1240x1240. Wide-field fundus photograph of an infant. Camera: Phoenix ICON (100° FOV)
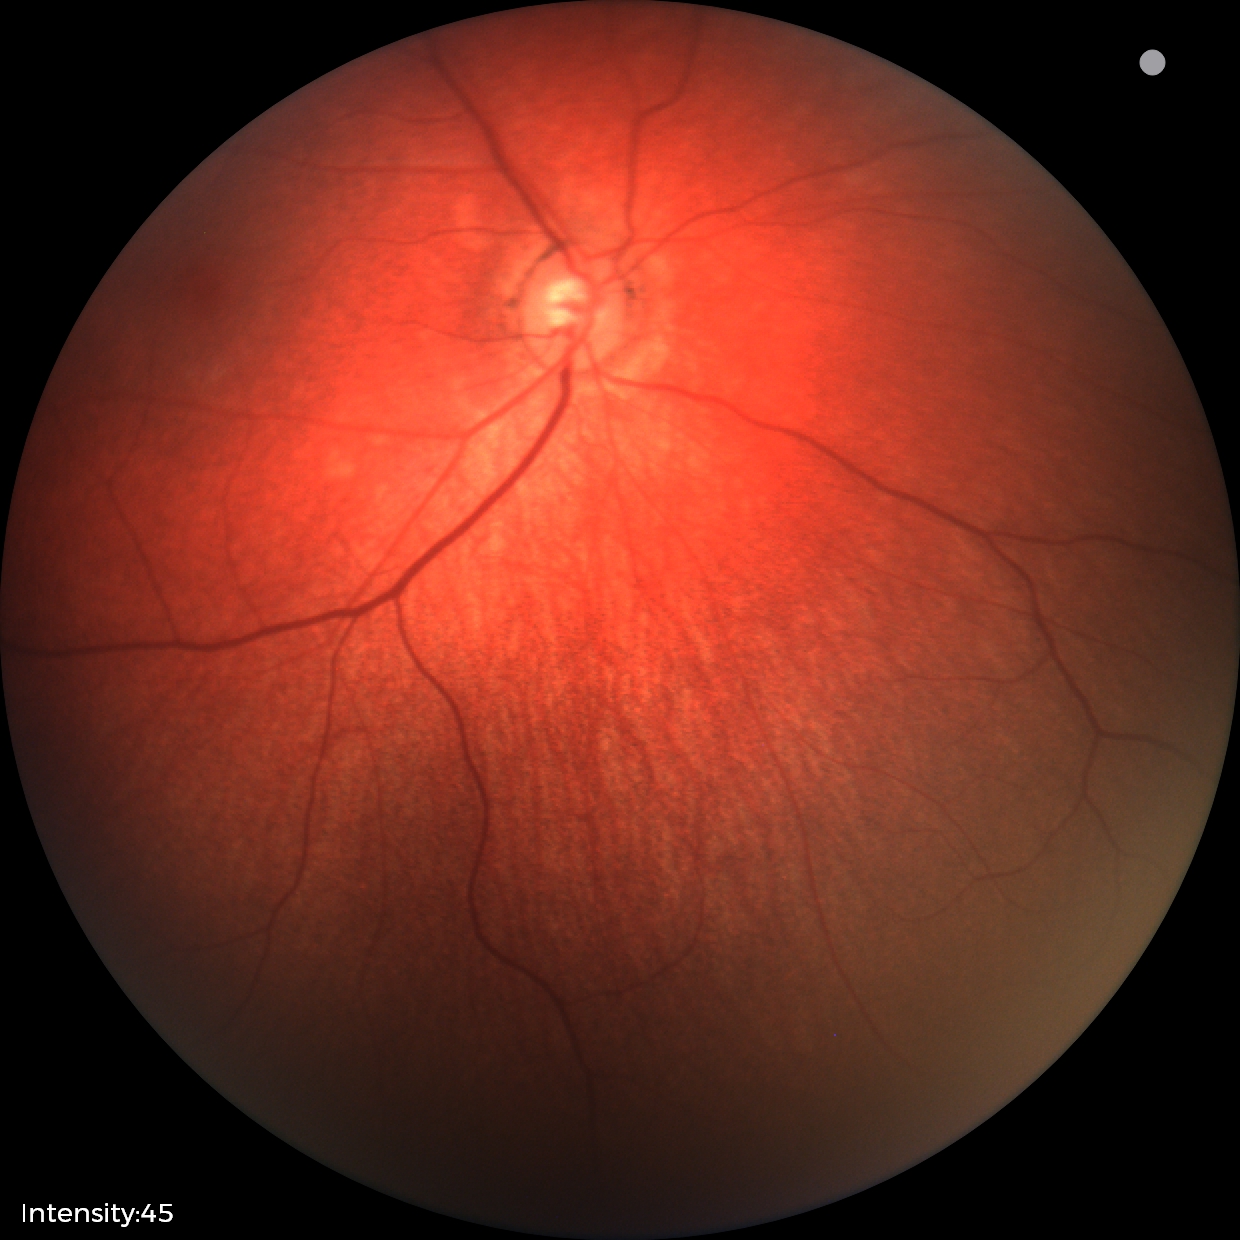

Diagnosis = no pathology identified